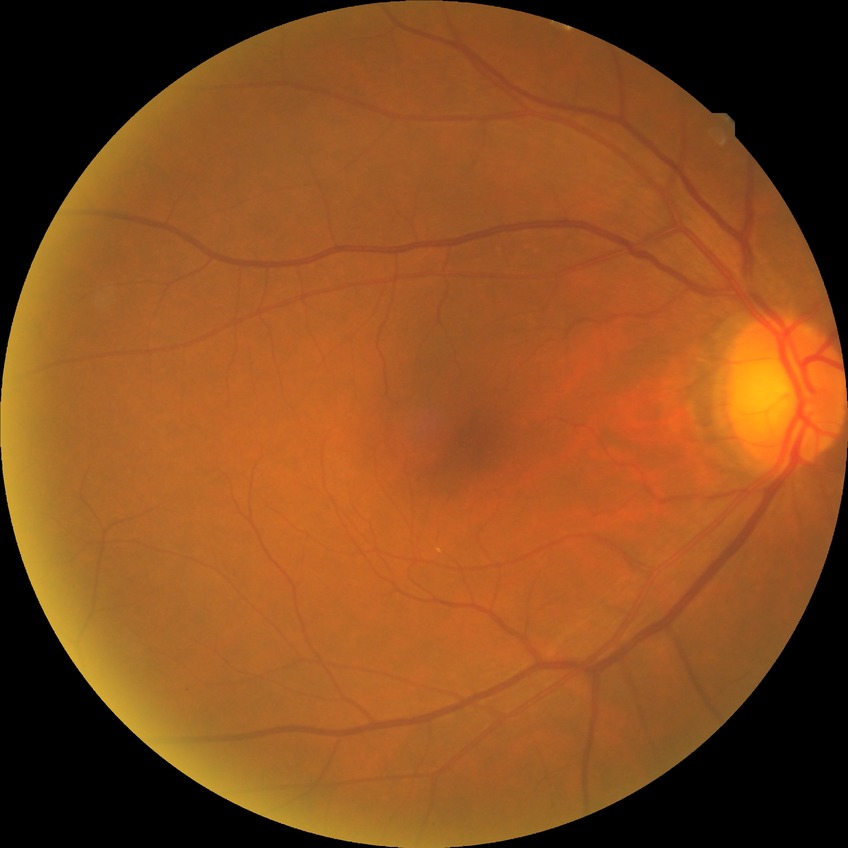 diabetic retinopathy (DR) = NDR (no diabetic retinopathy).